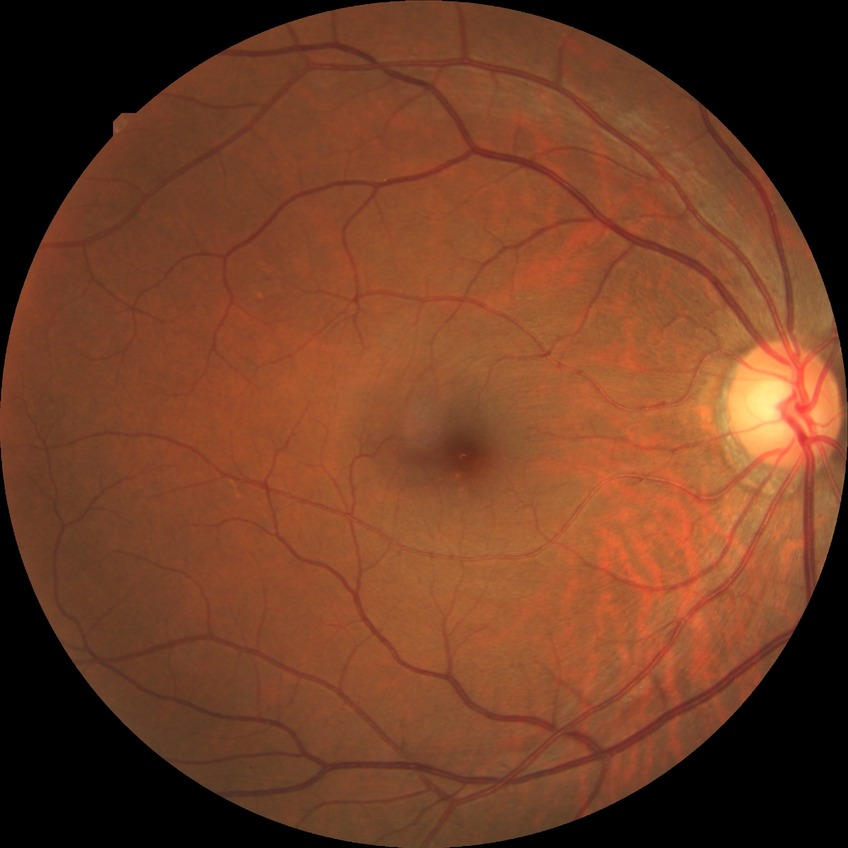 modified Davis classification = no diabetic retinopathy.